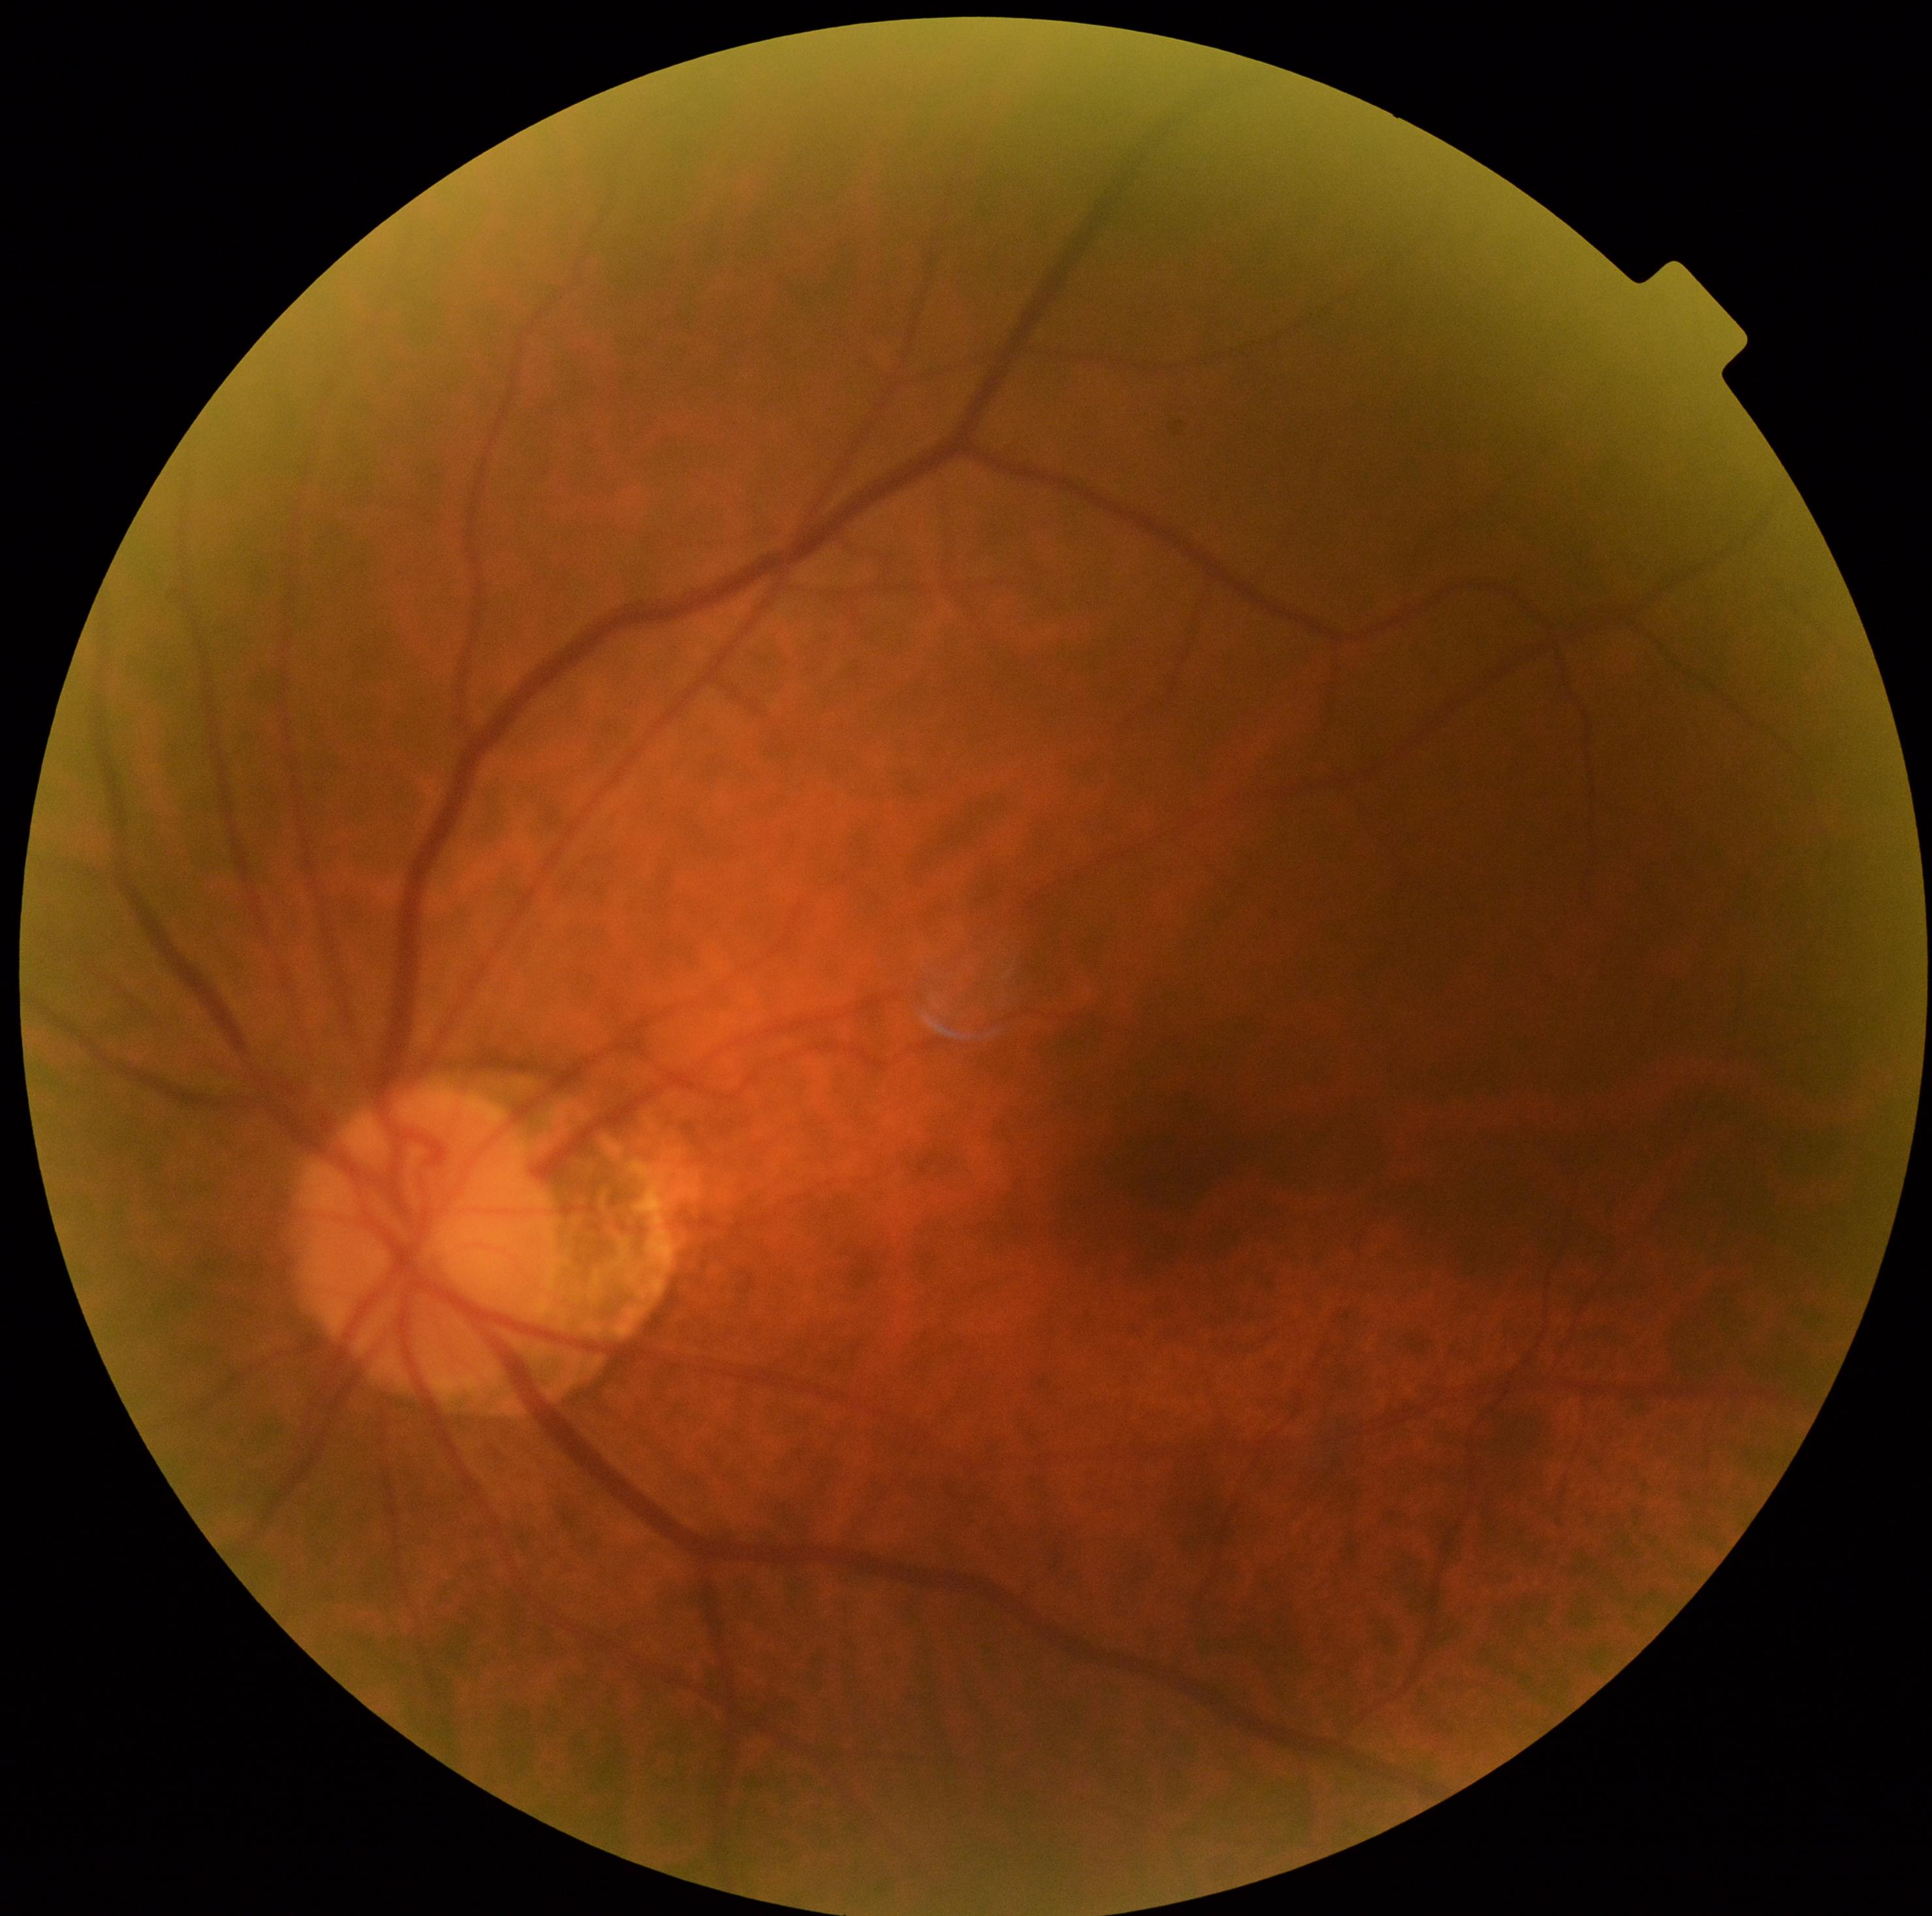

Diabetic retinopathy (DR) is no apparent diabetic retinopathy (grade 0).